1932x1910: 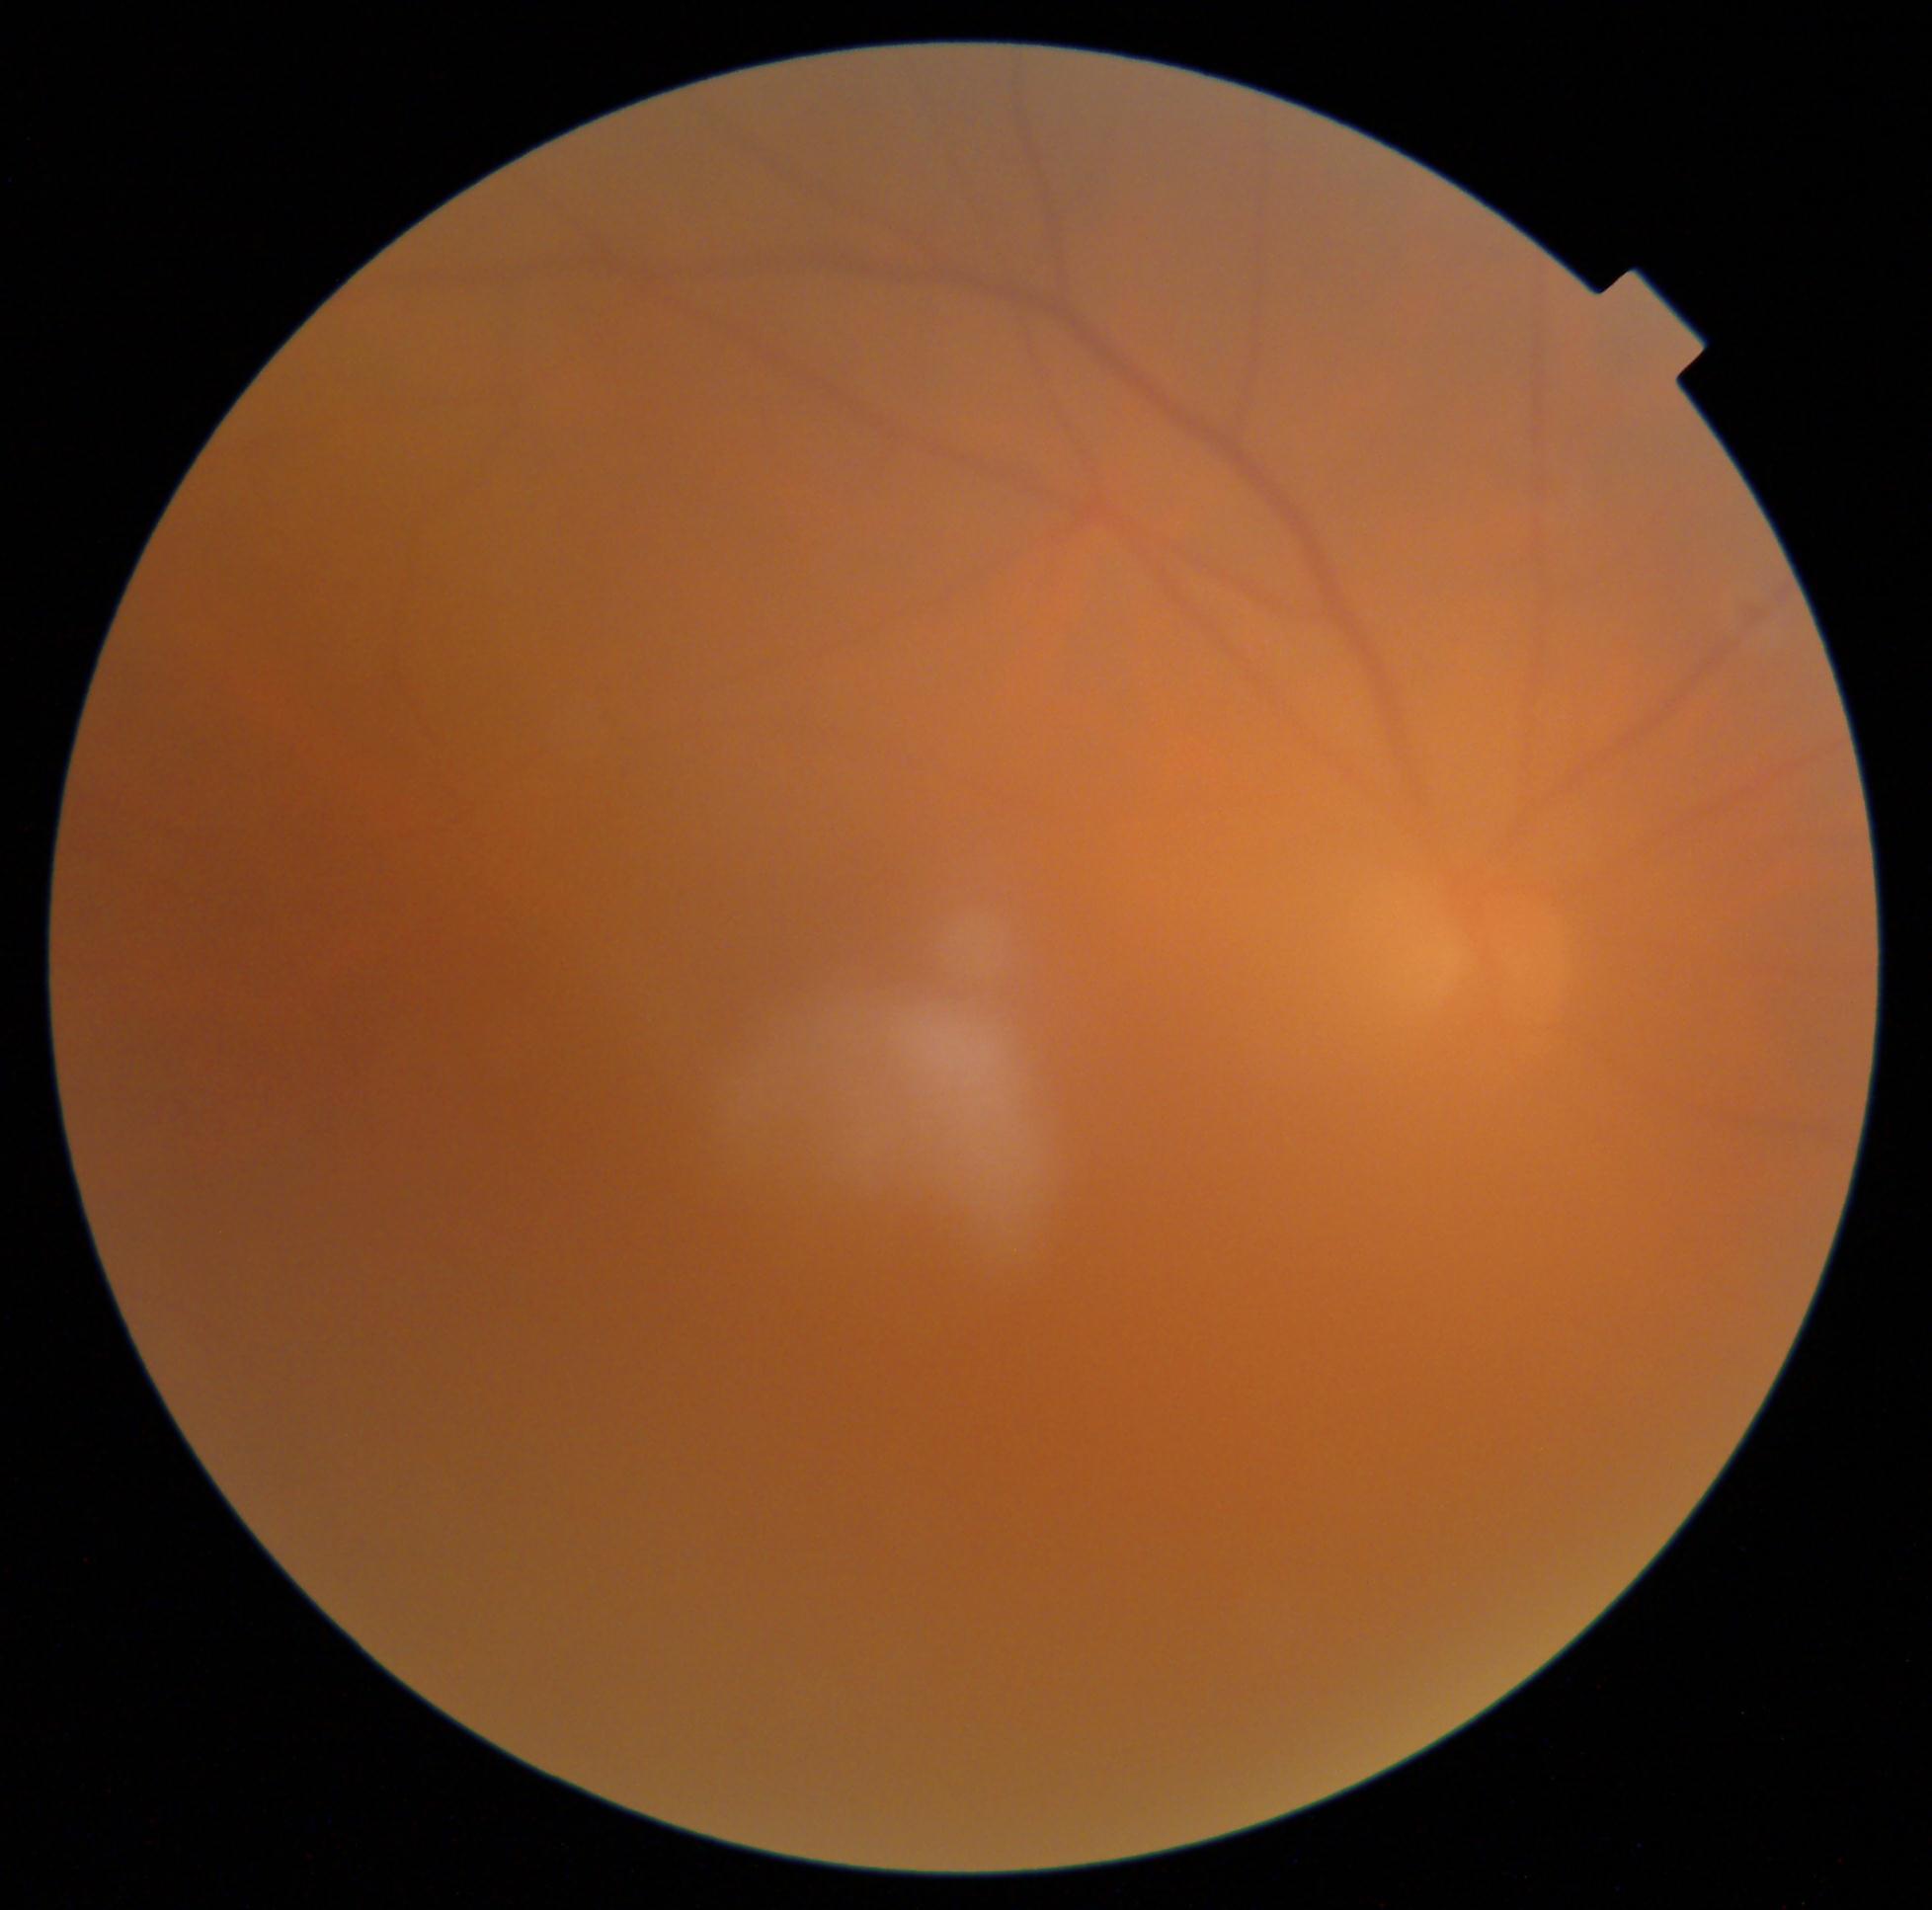 DR is ungradable due to poor image quality. The image cannot be graded for diabetic retinopathy.